FOV: 45 degrees.
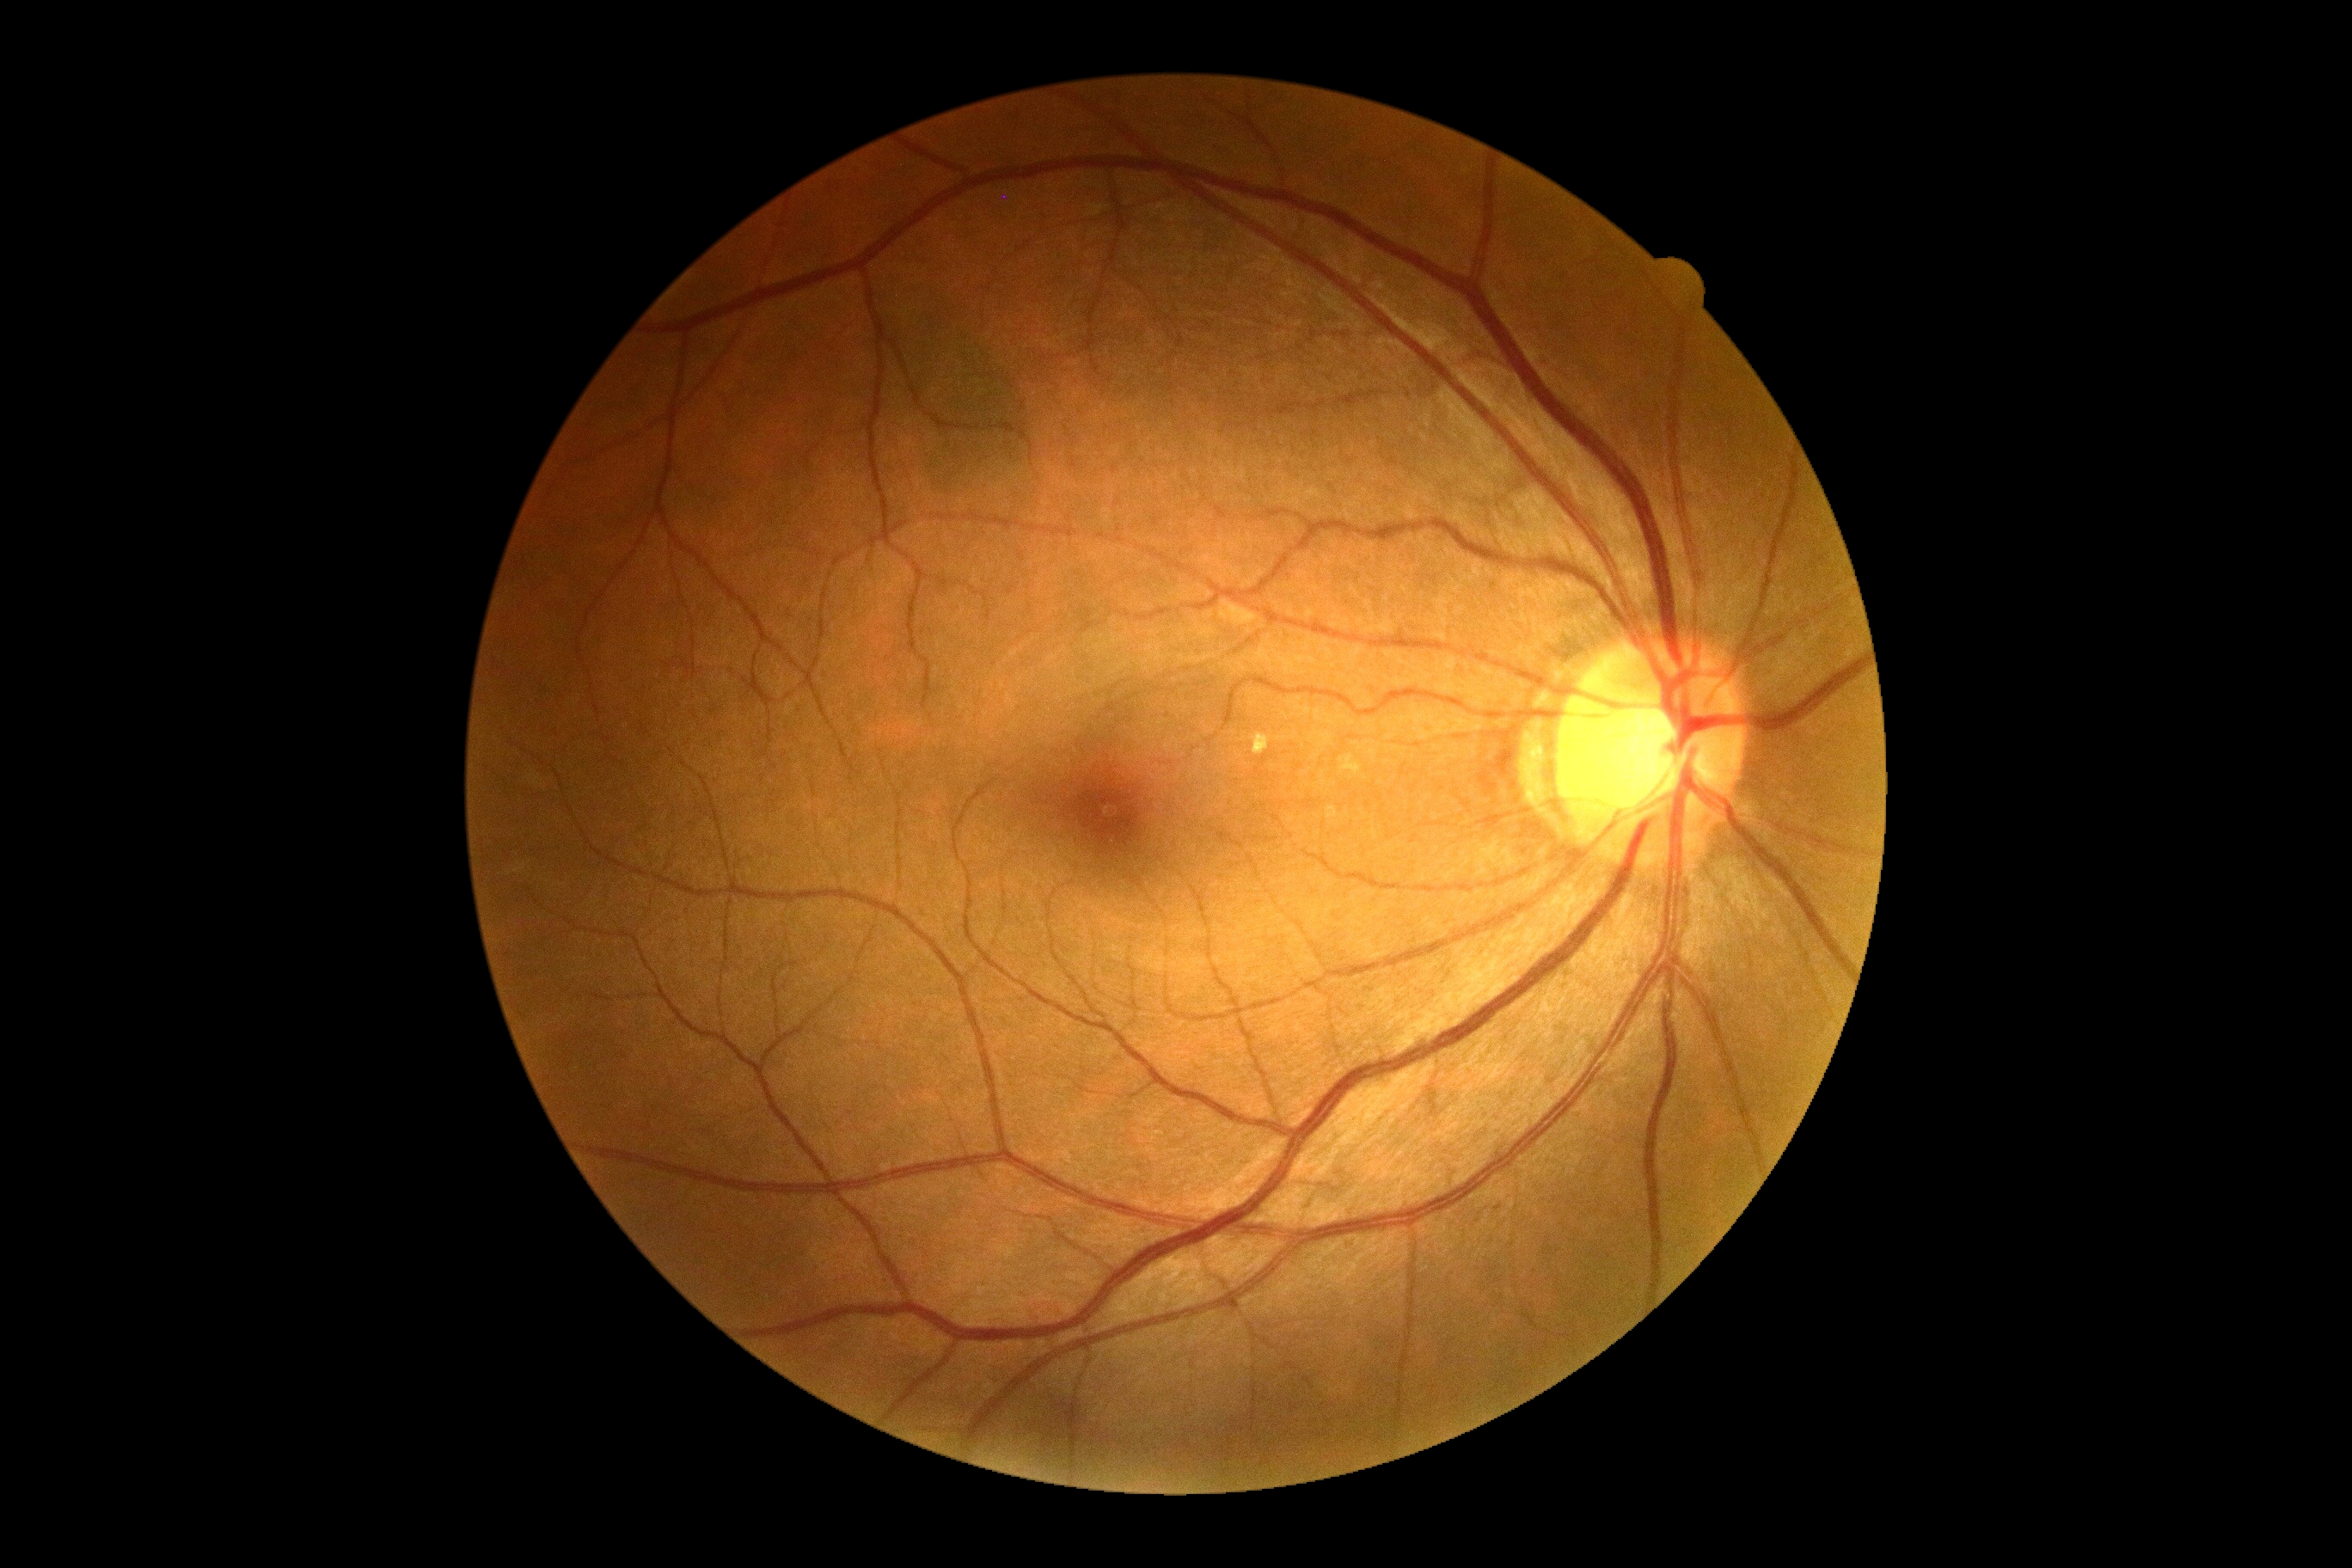

Diabetic retinopathy (DR) is no apparent diabetic retinopathy (grade 0).
No DR findings.